Remidio smartphone fundus camera: 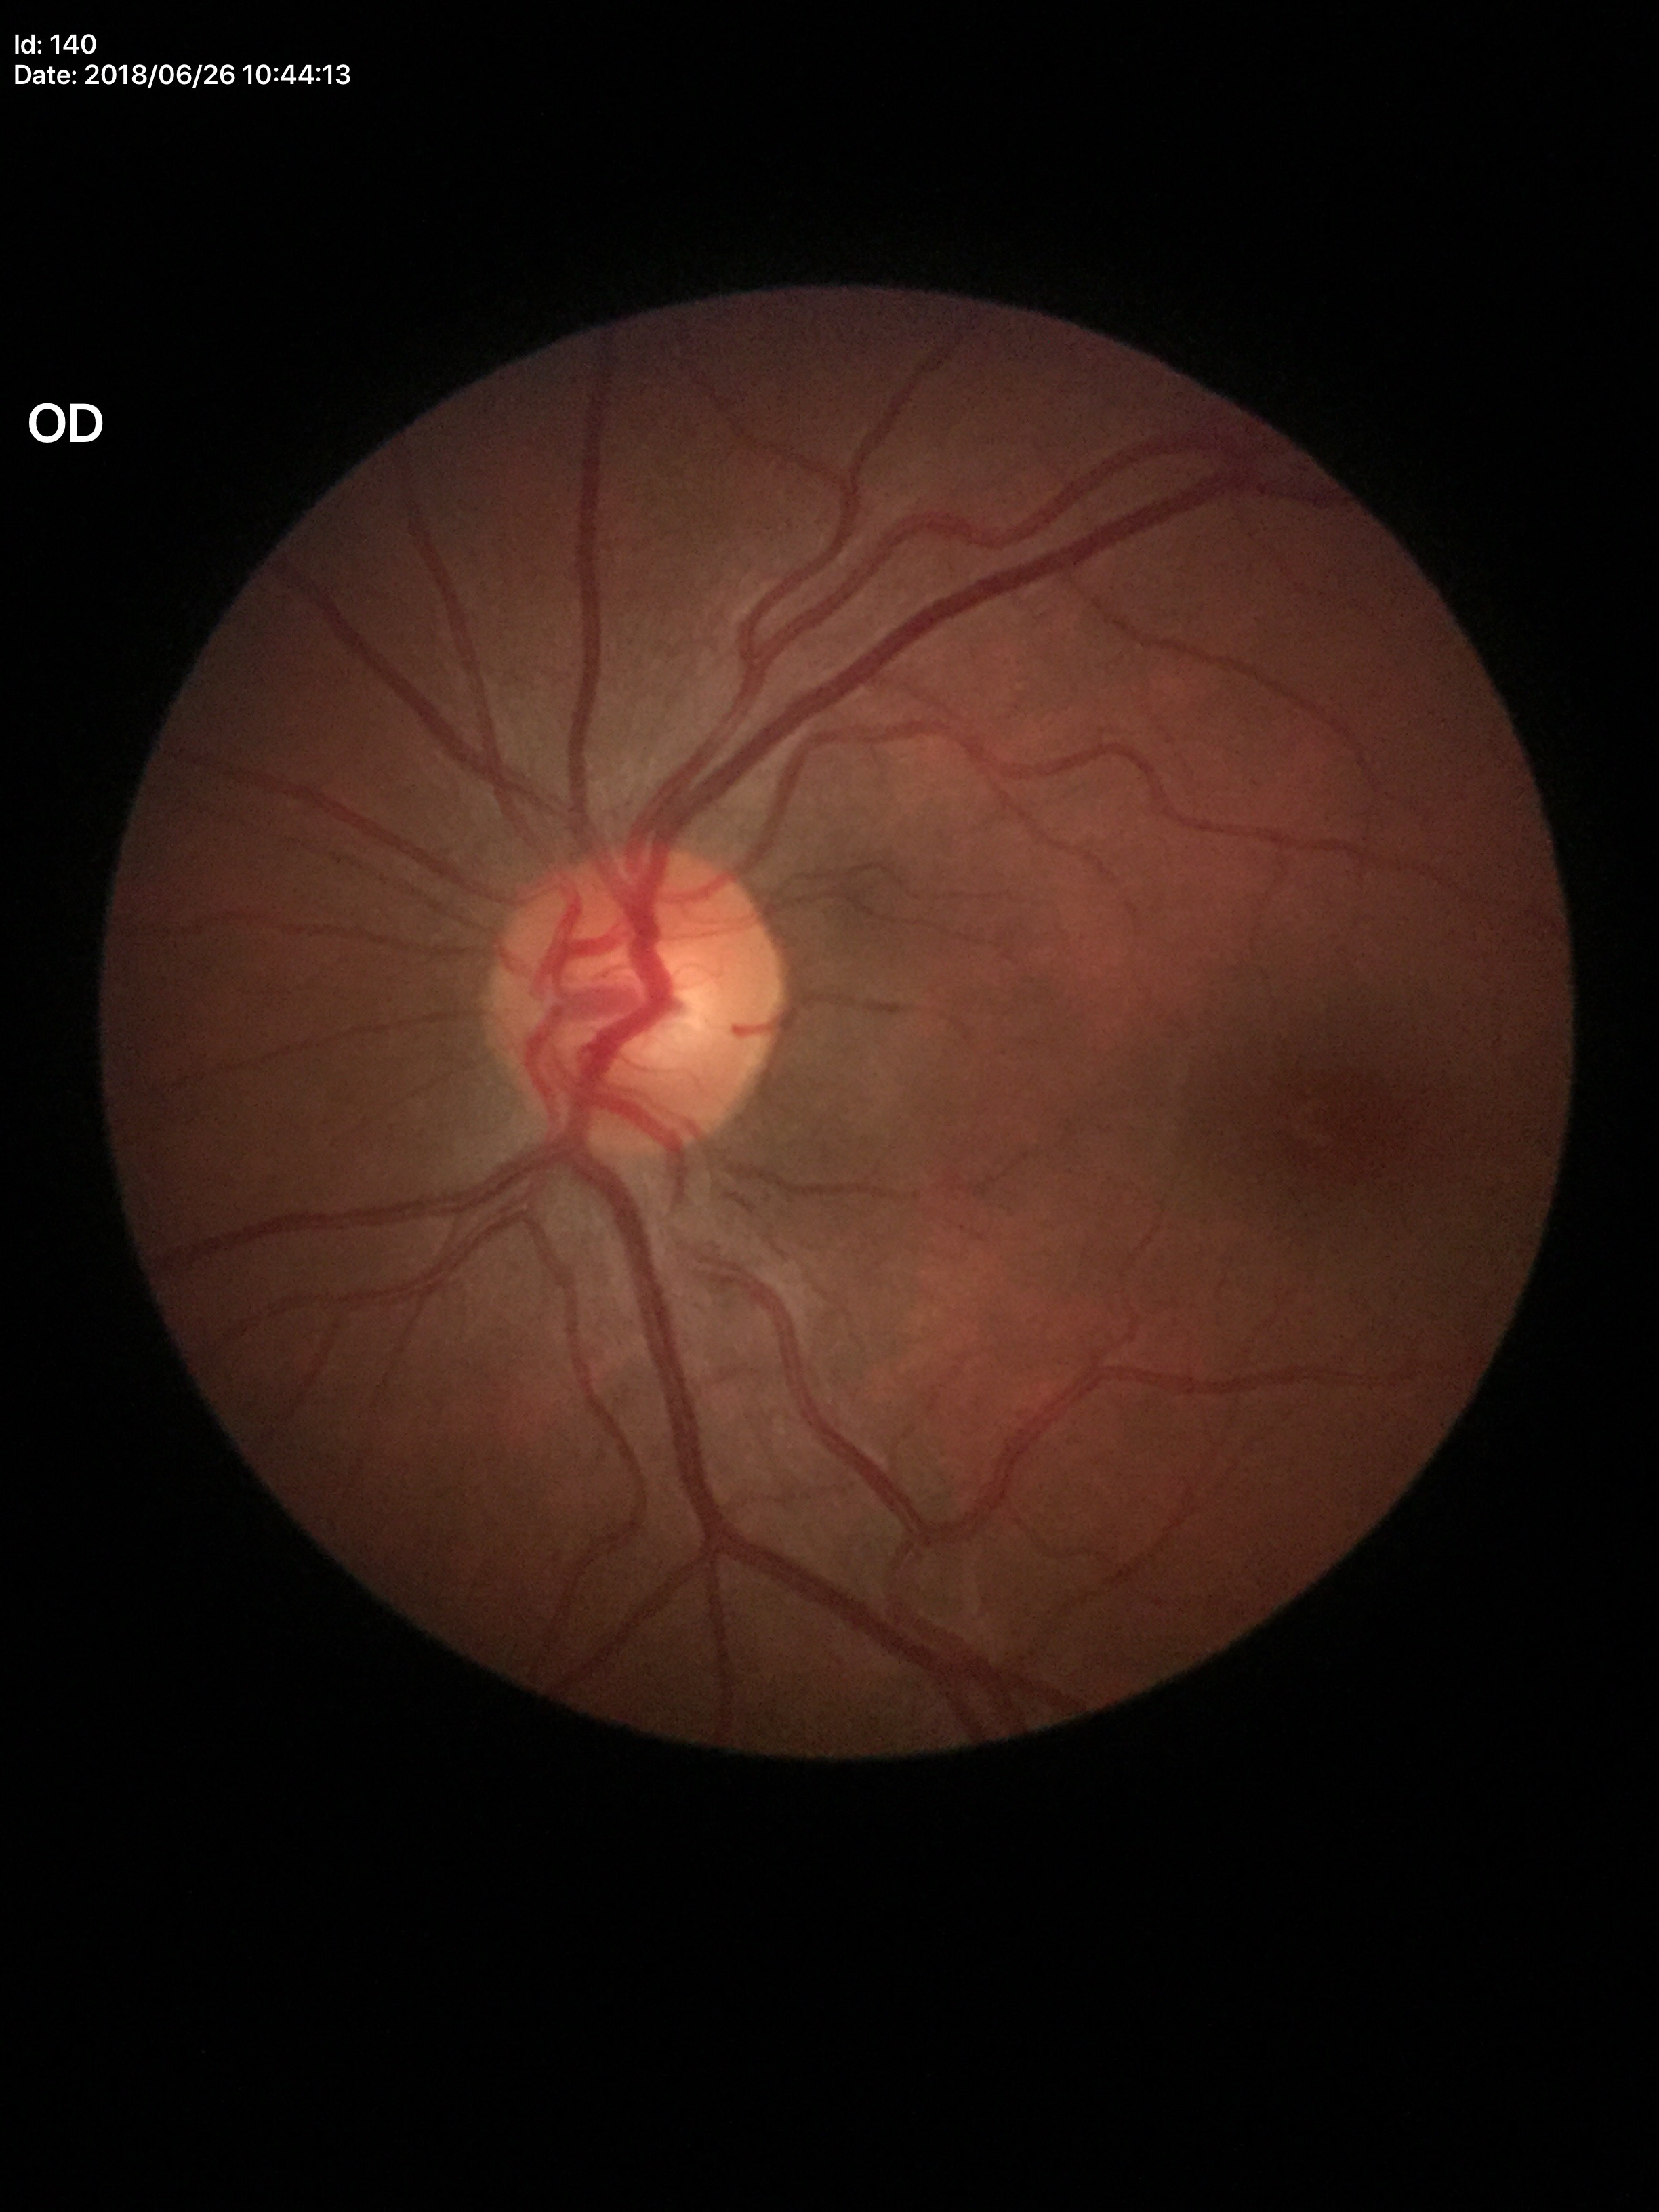

horizontal cup-disc ratio: 0.55; Glaucoma assessment: no suspicious findings; vertical C/D ratio: 0.52